45-degree field of view, modified Davis grading.
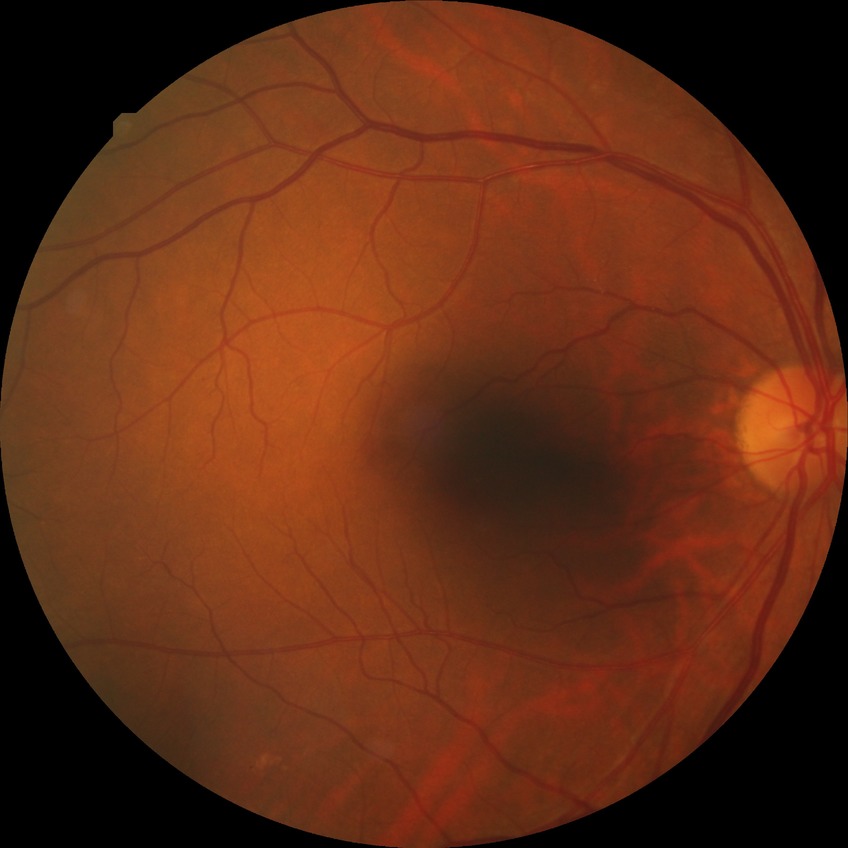

diabetic retinopathy grade: no diabetic retinopathy.